2048x1536; 45° FOV; CFP — 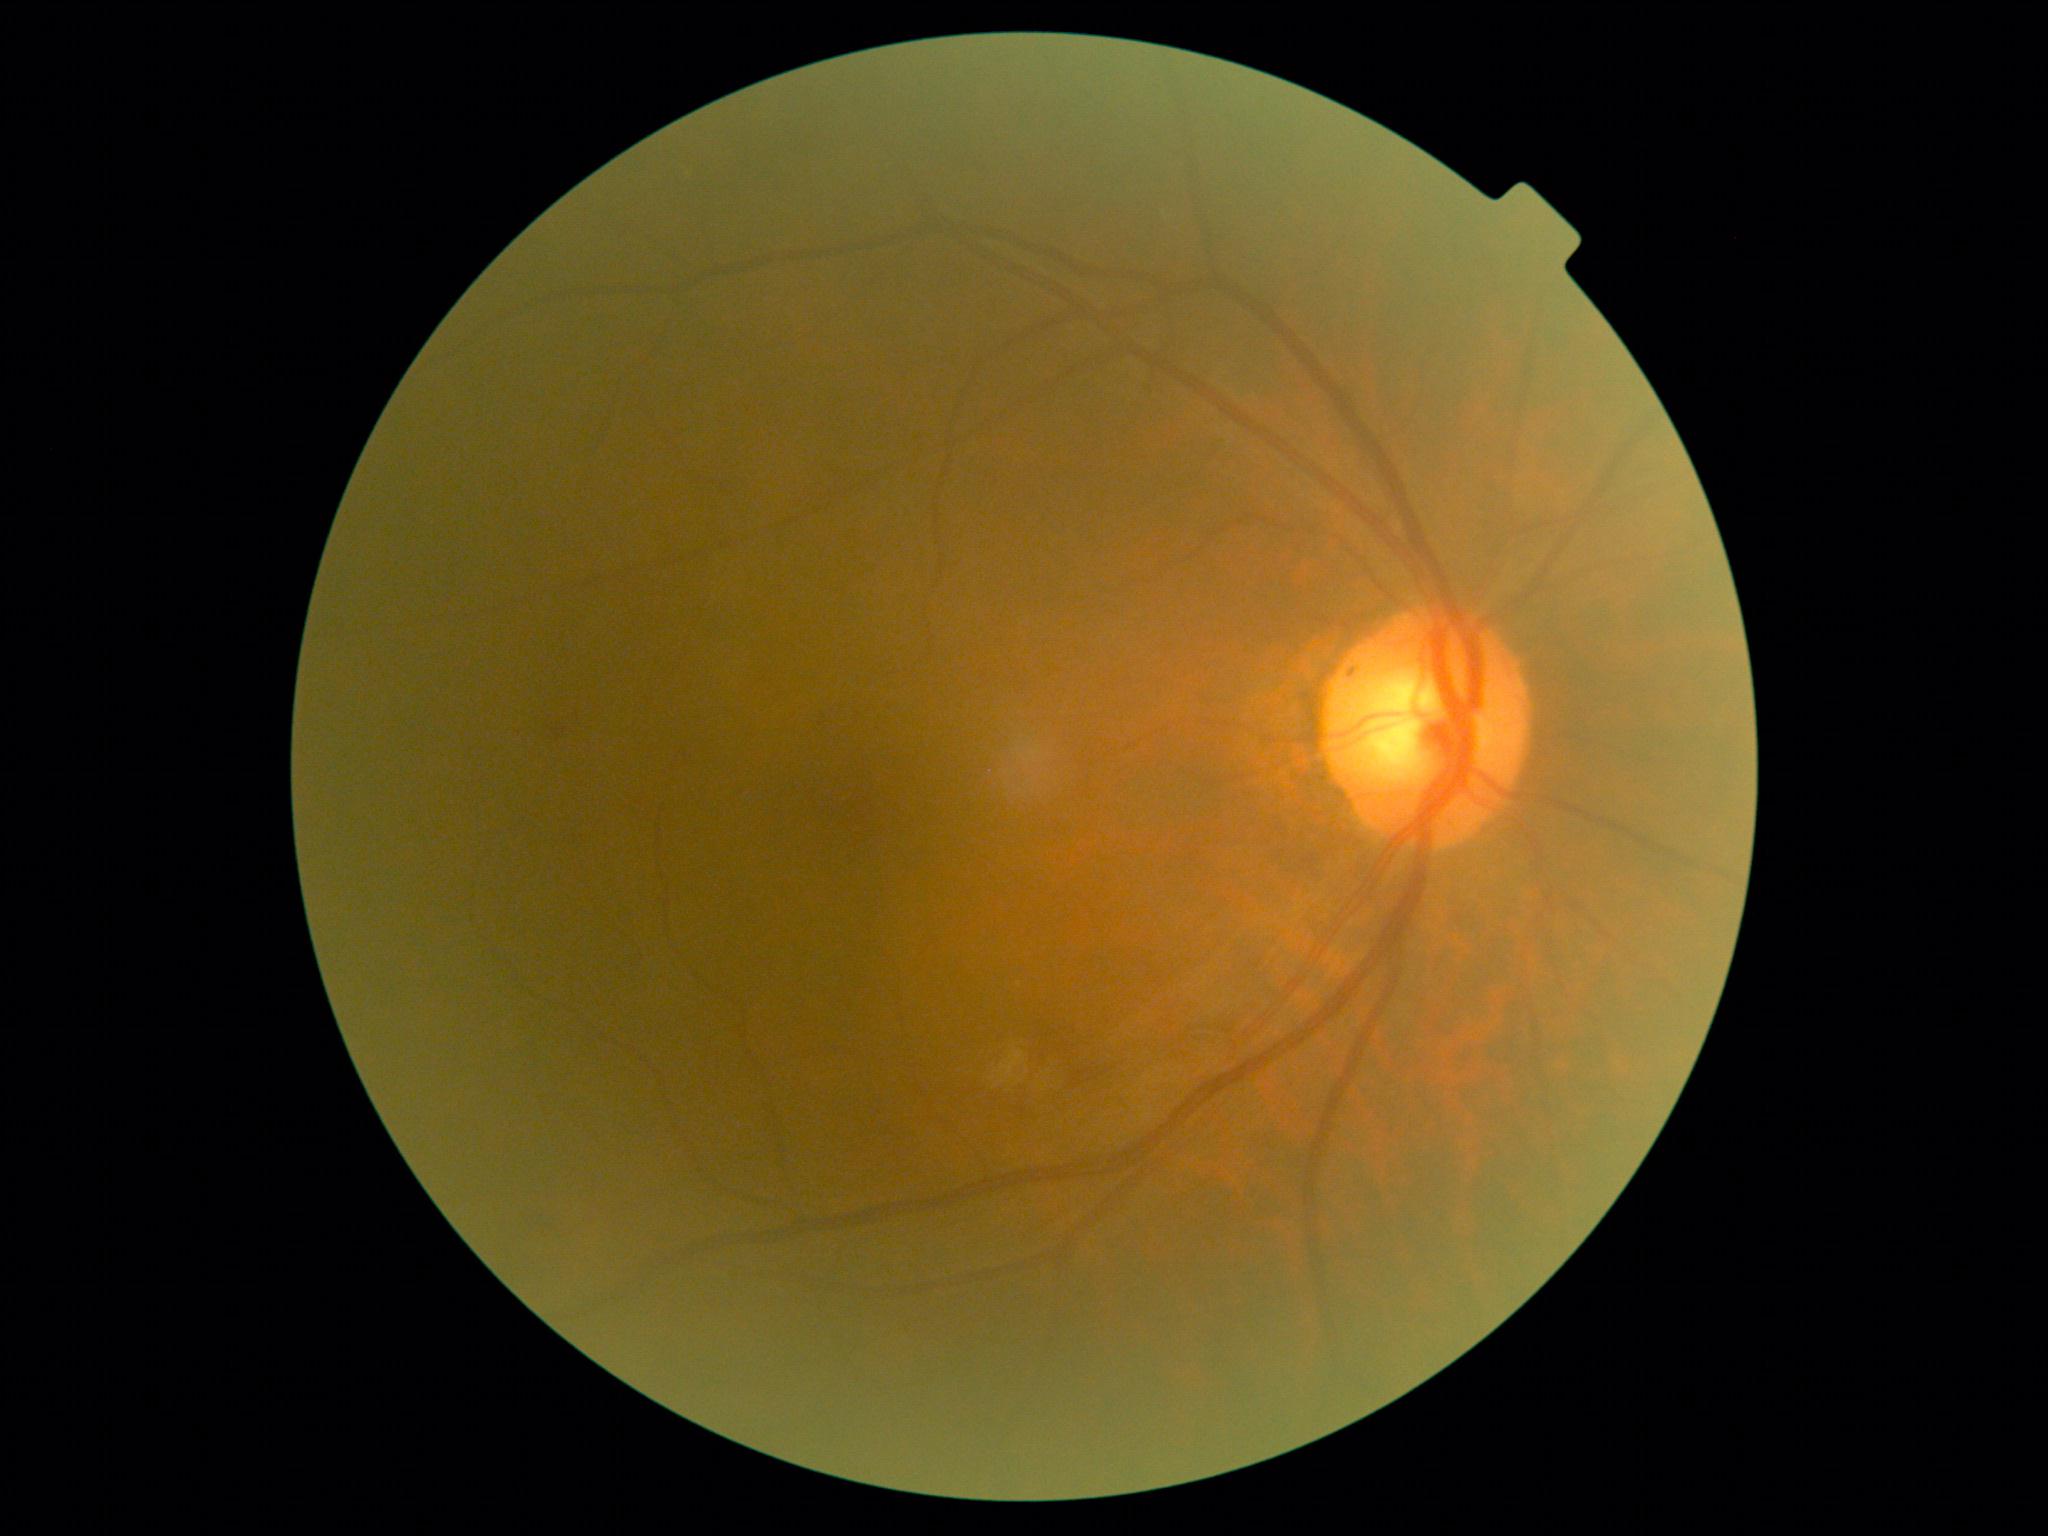 {
  "dr_grade": "2",
  "dr_category": "non-proliferative diabetic retinopathy"
}